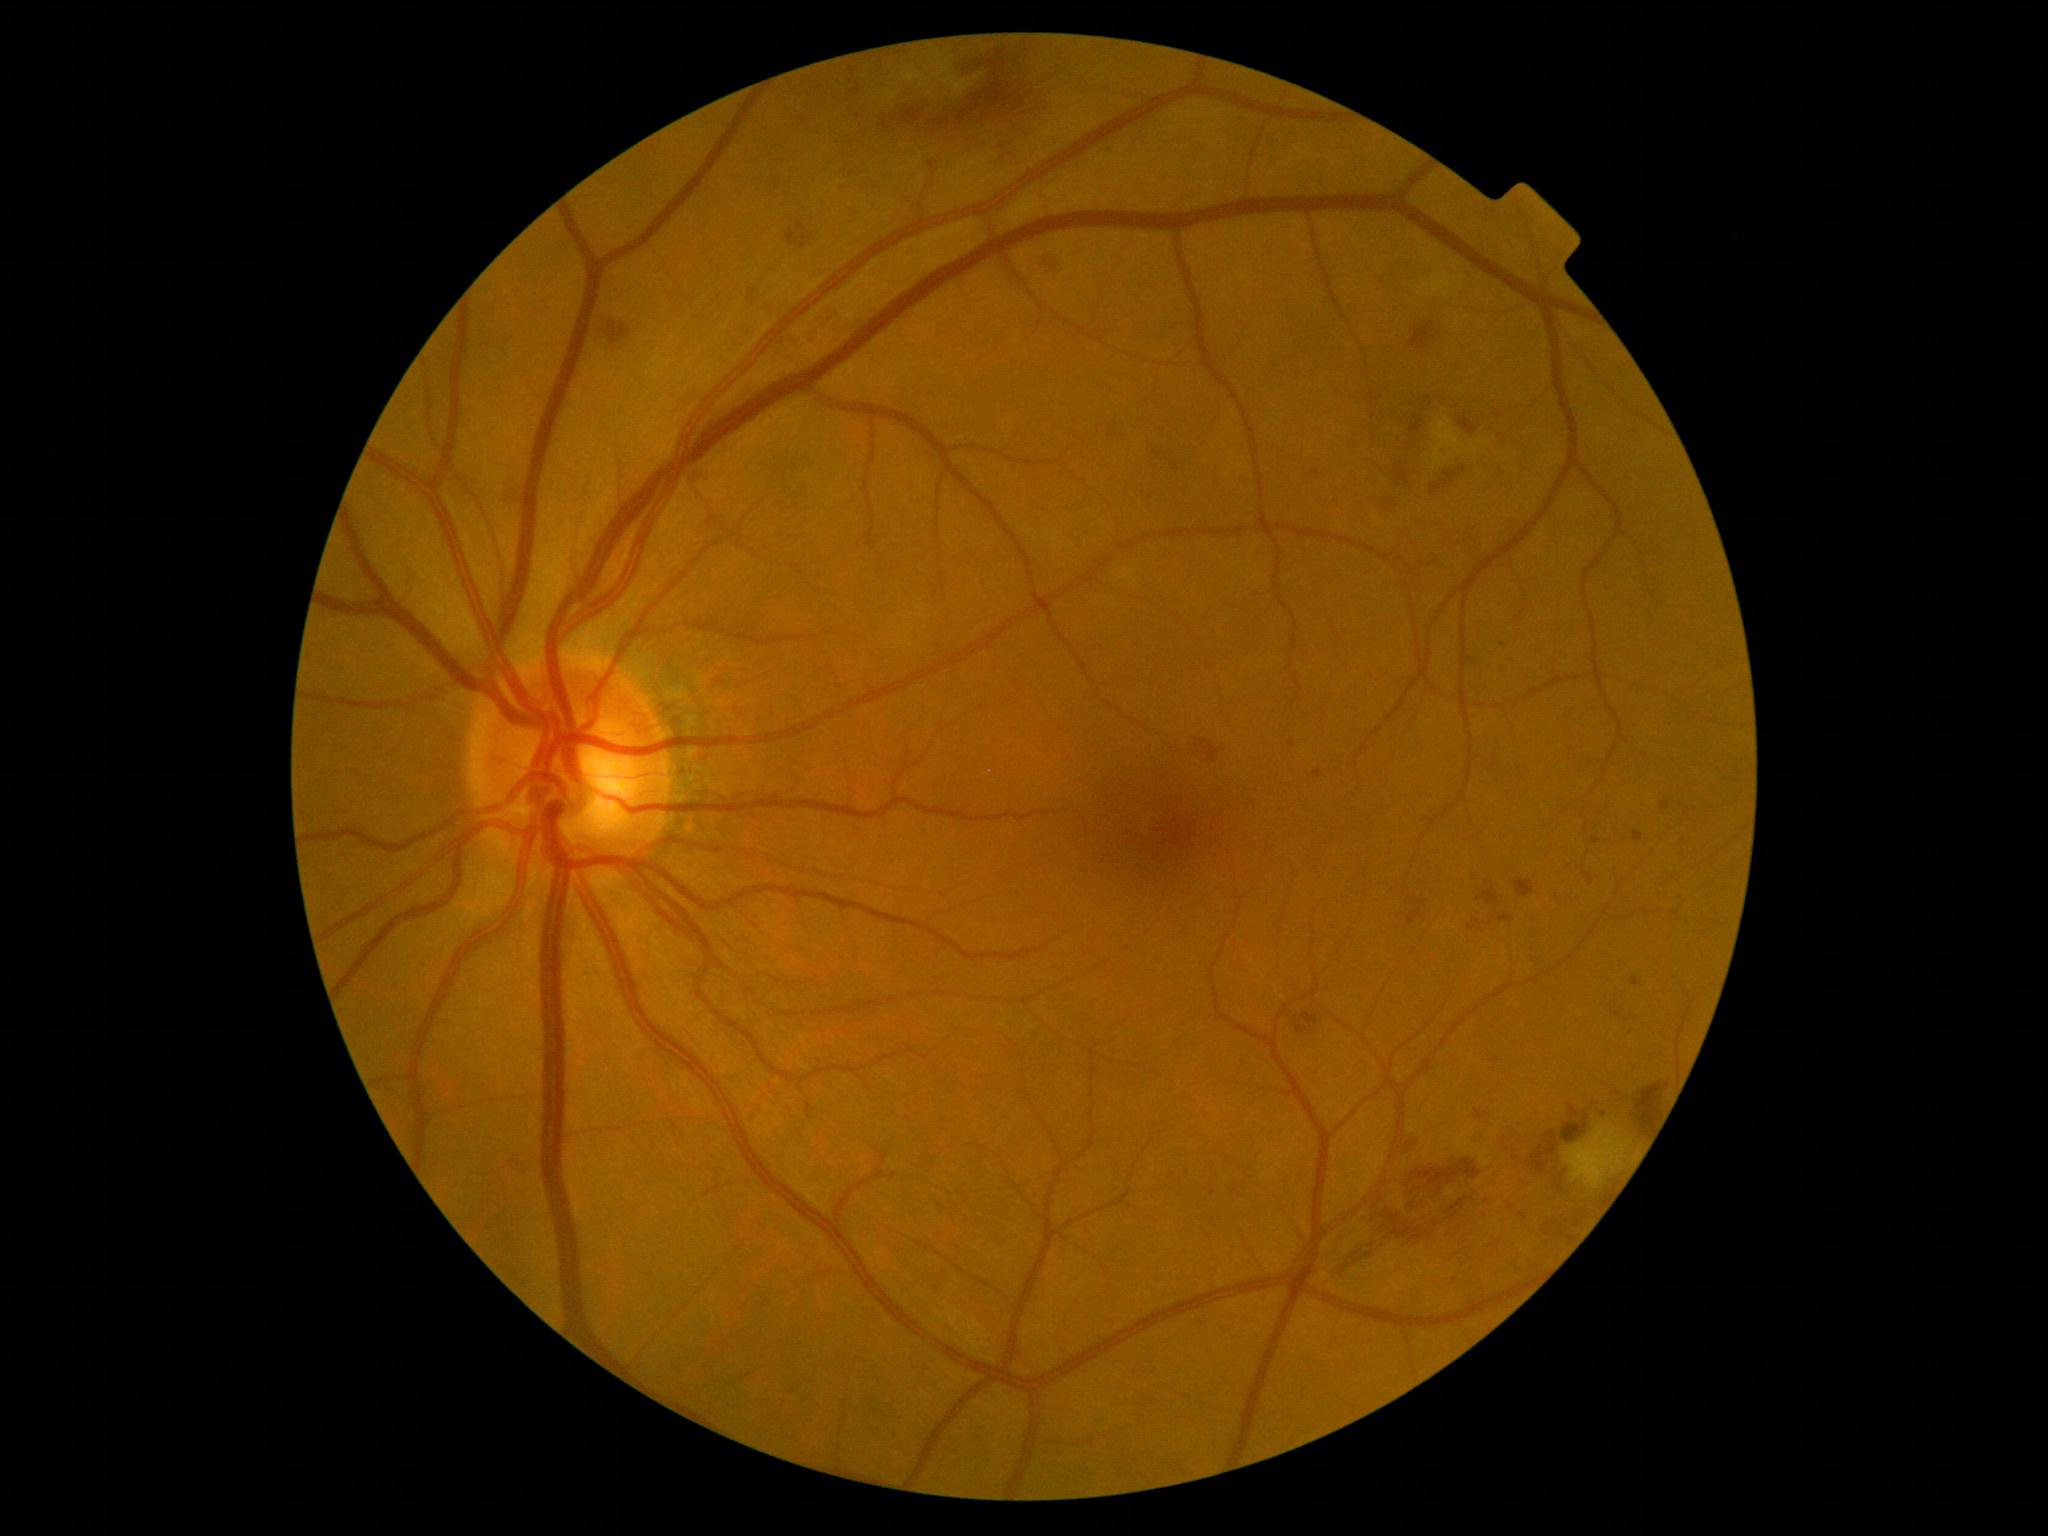 {
  "dr_grade": "2 — more than just microaneurysms but less than severe NPDR"
}